CFP
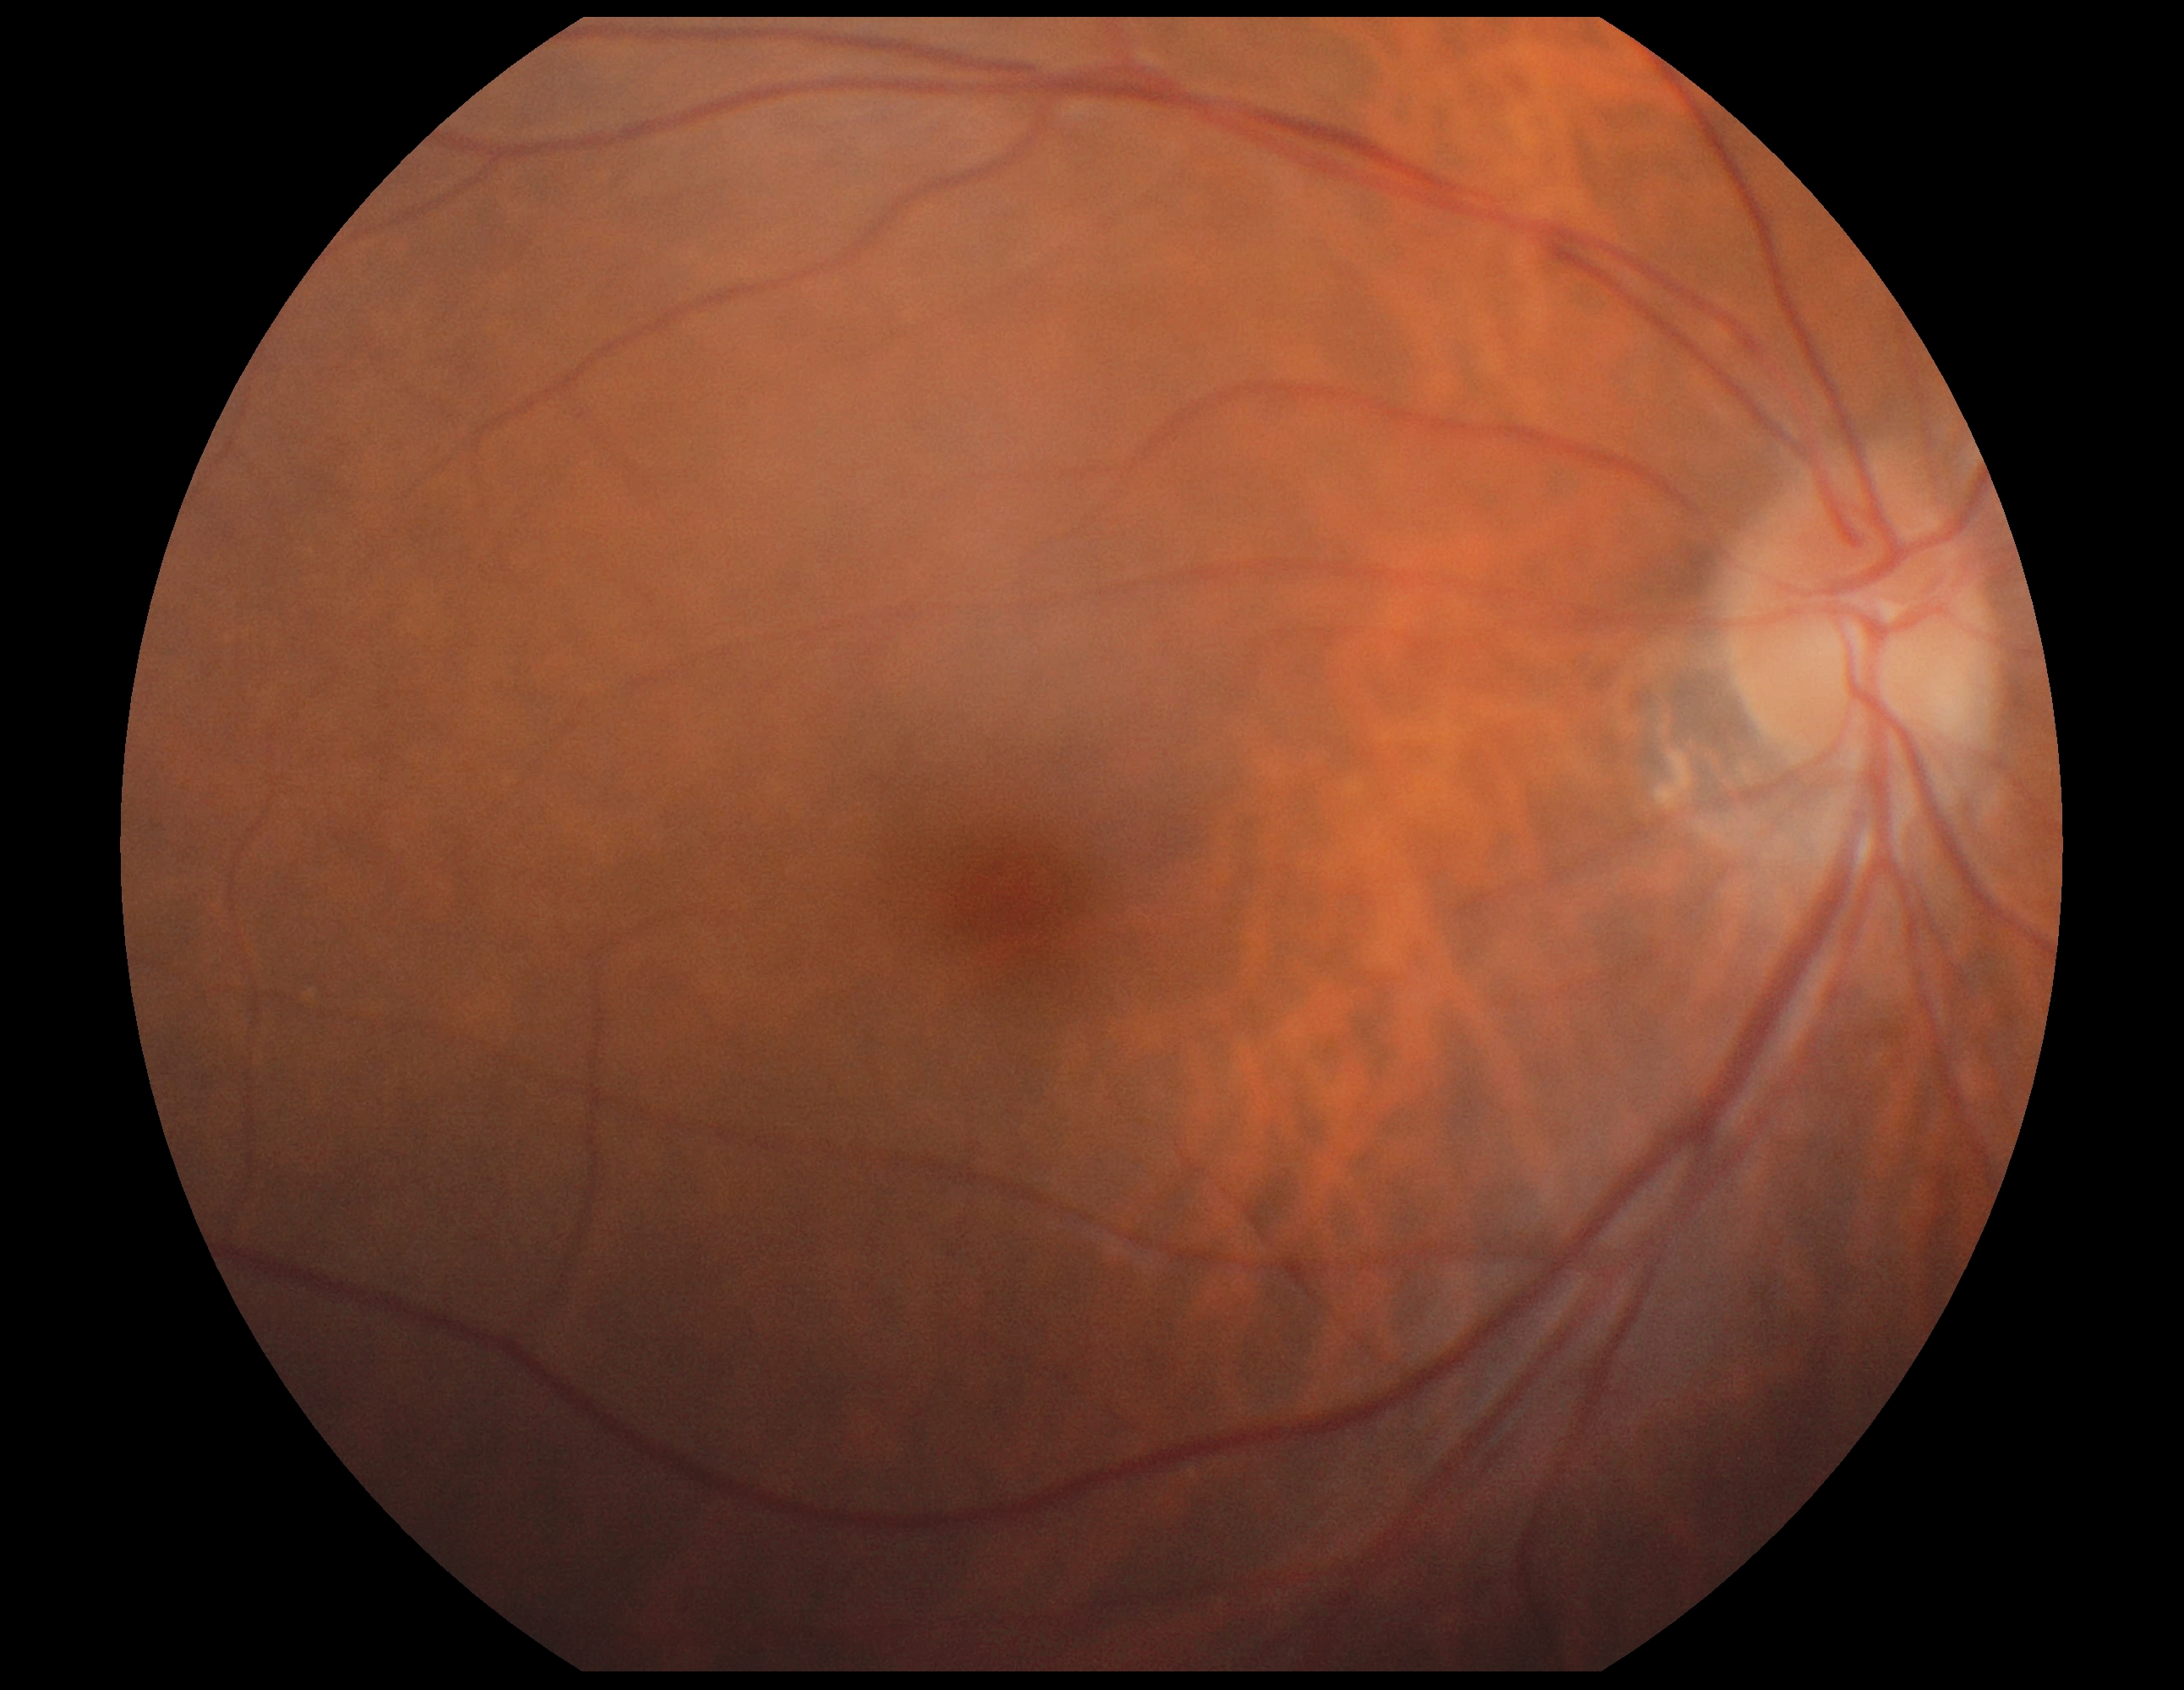

diabetic retinopathy grade=0/4.